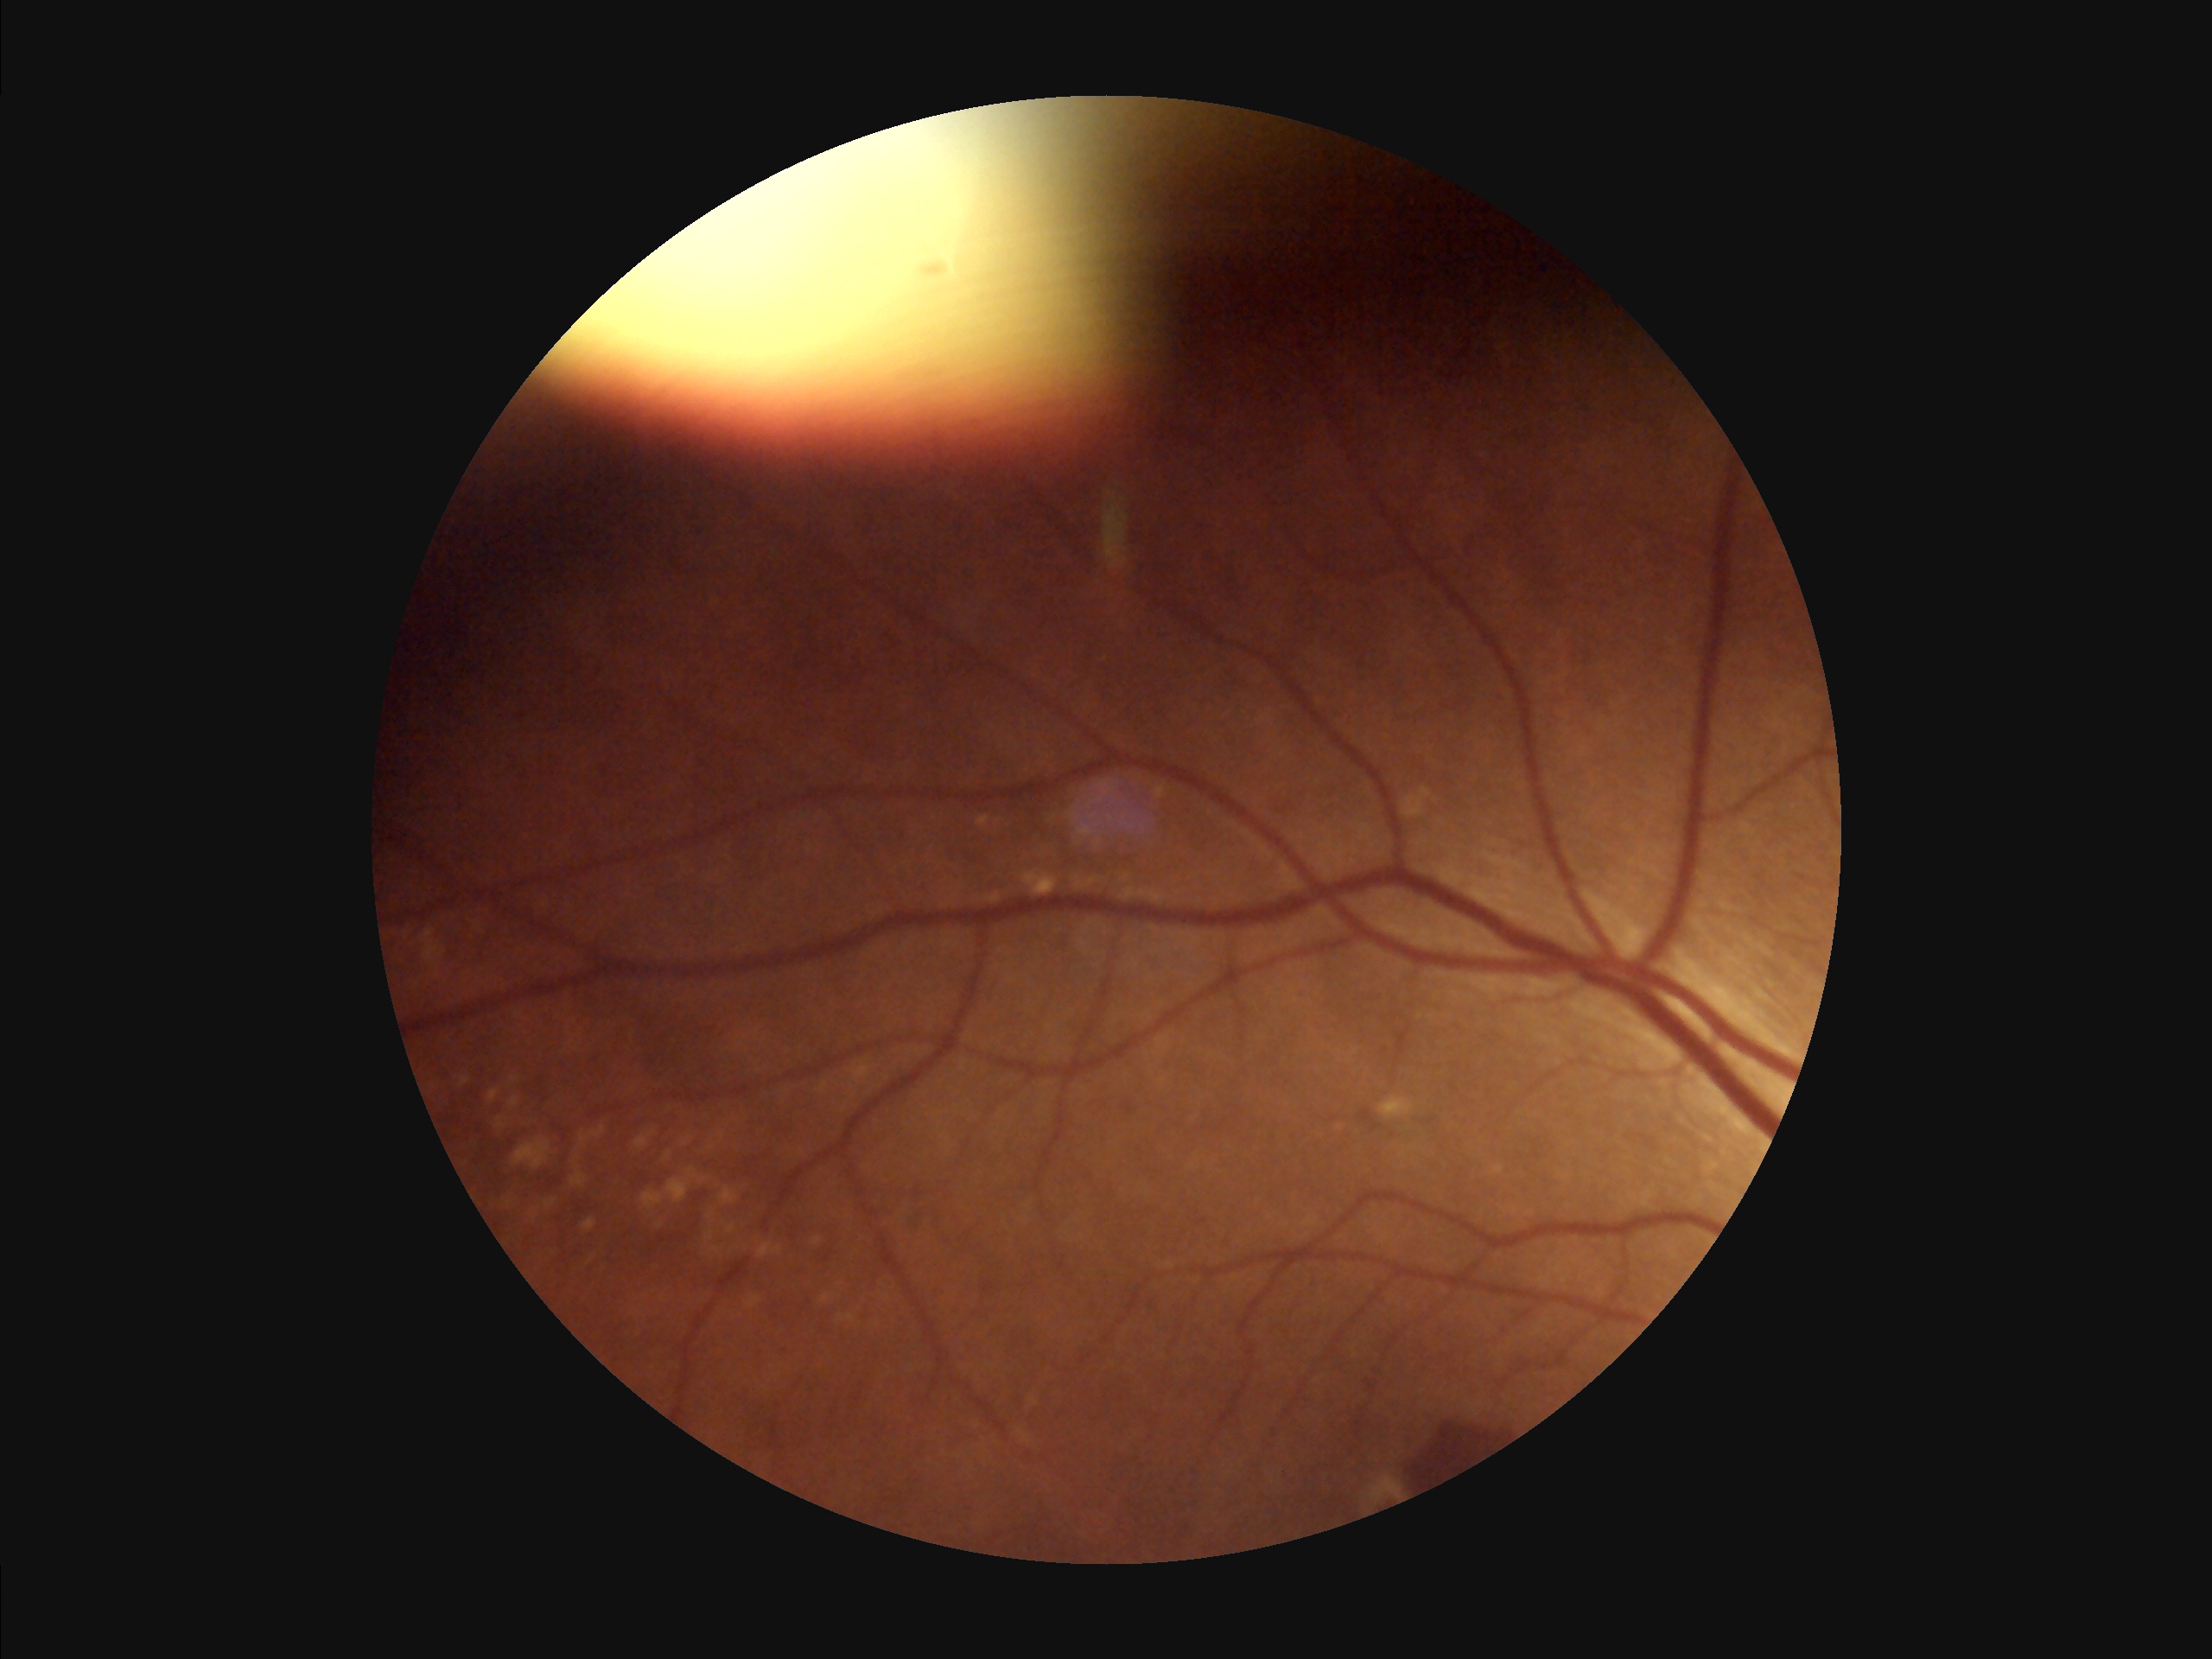
Contrast = good; Illumination = suboptimal; Focus = sharp; Overall = low.